Fundus photo
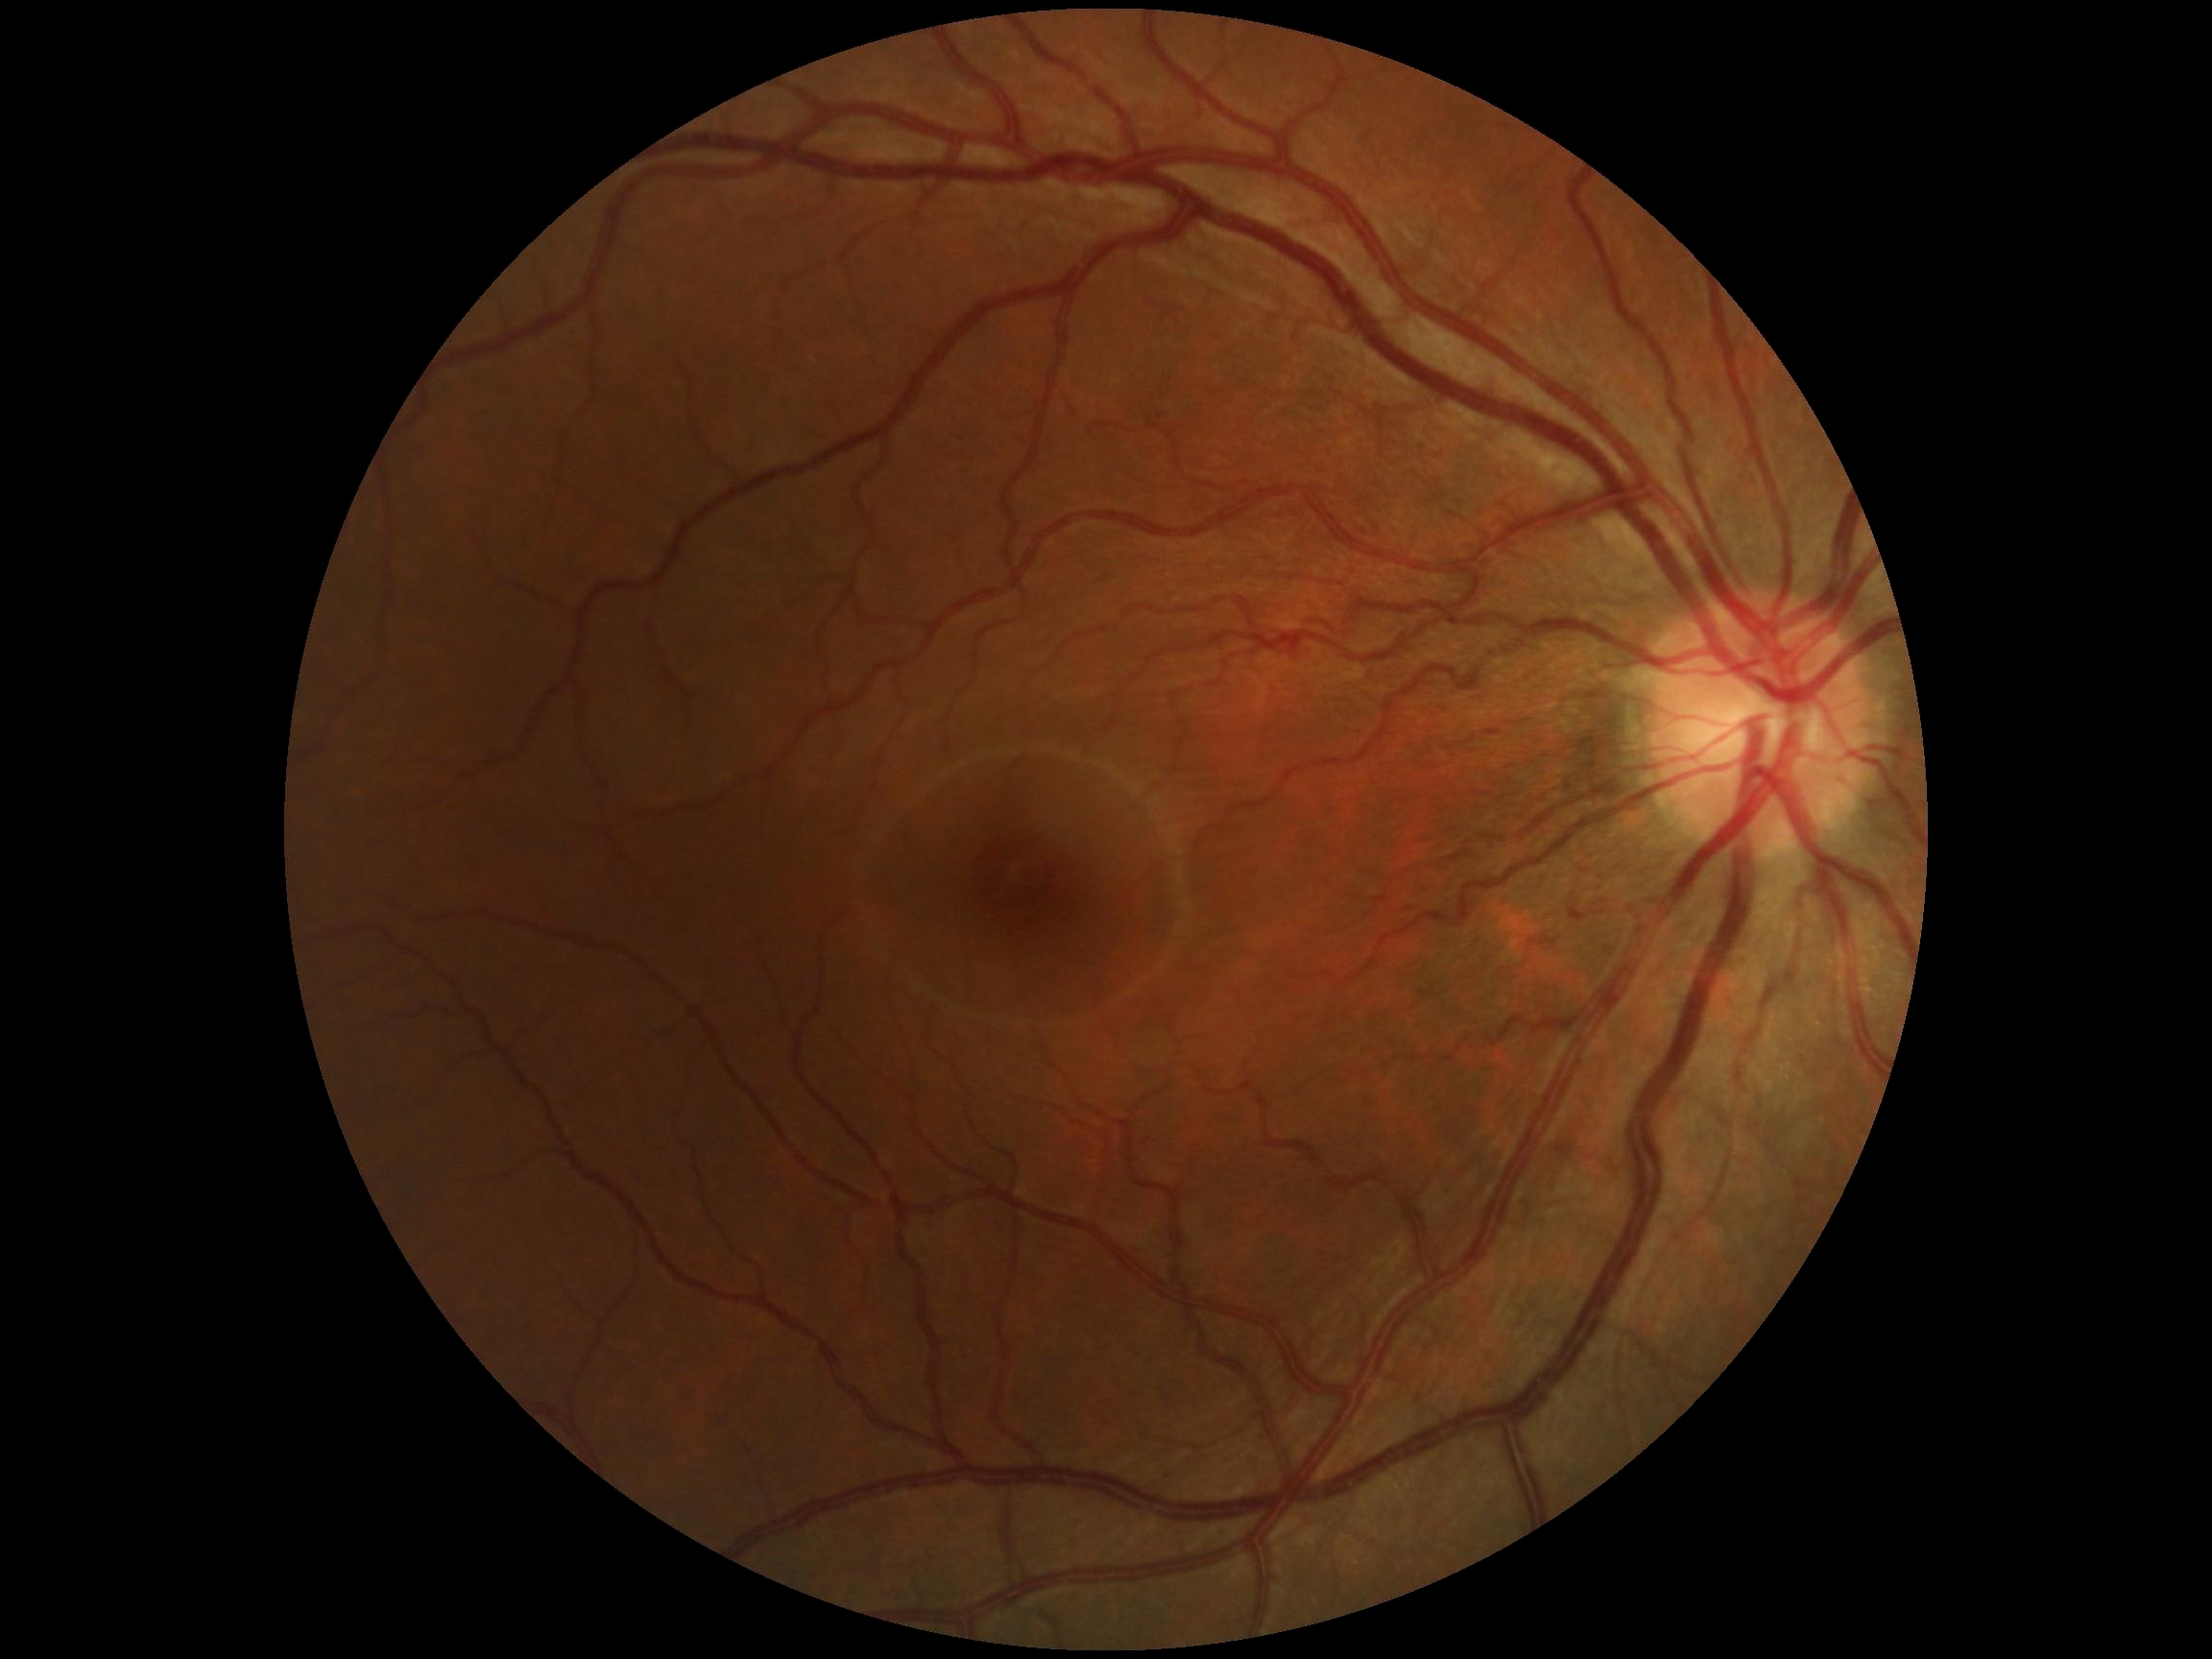 No signs of diabetic retinopathy. Diabetic retinopathy is no apparent diabetic retinopathy (grade 0) — no visible signs of diabetic retinopathy.